Disc-centered field, acquired with a Nidek AFC-330: 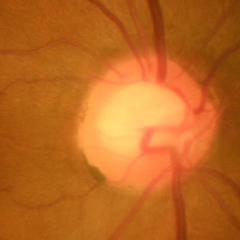
No evidence of glaucoma.